Wide-field fundus image from infant ROP screening. Camera: Phoenix ICON (100° FOV)
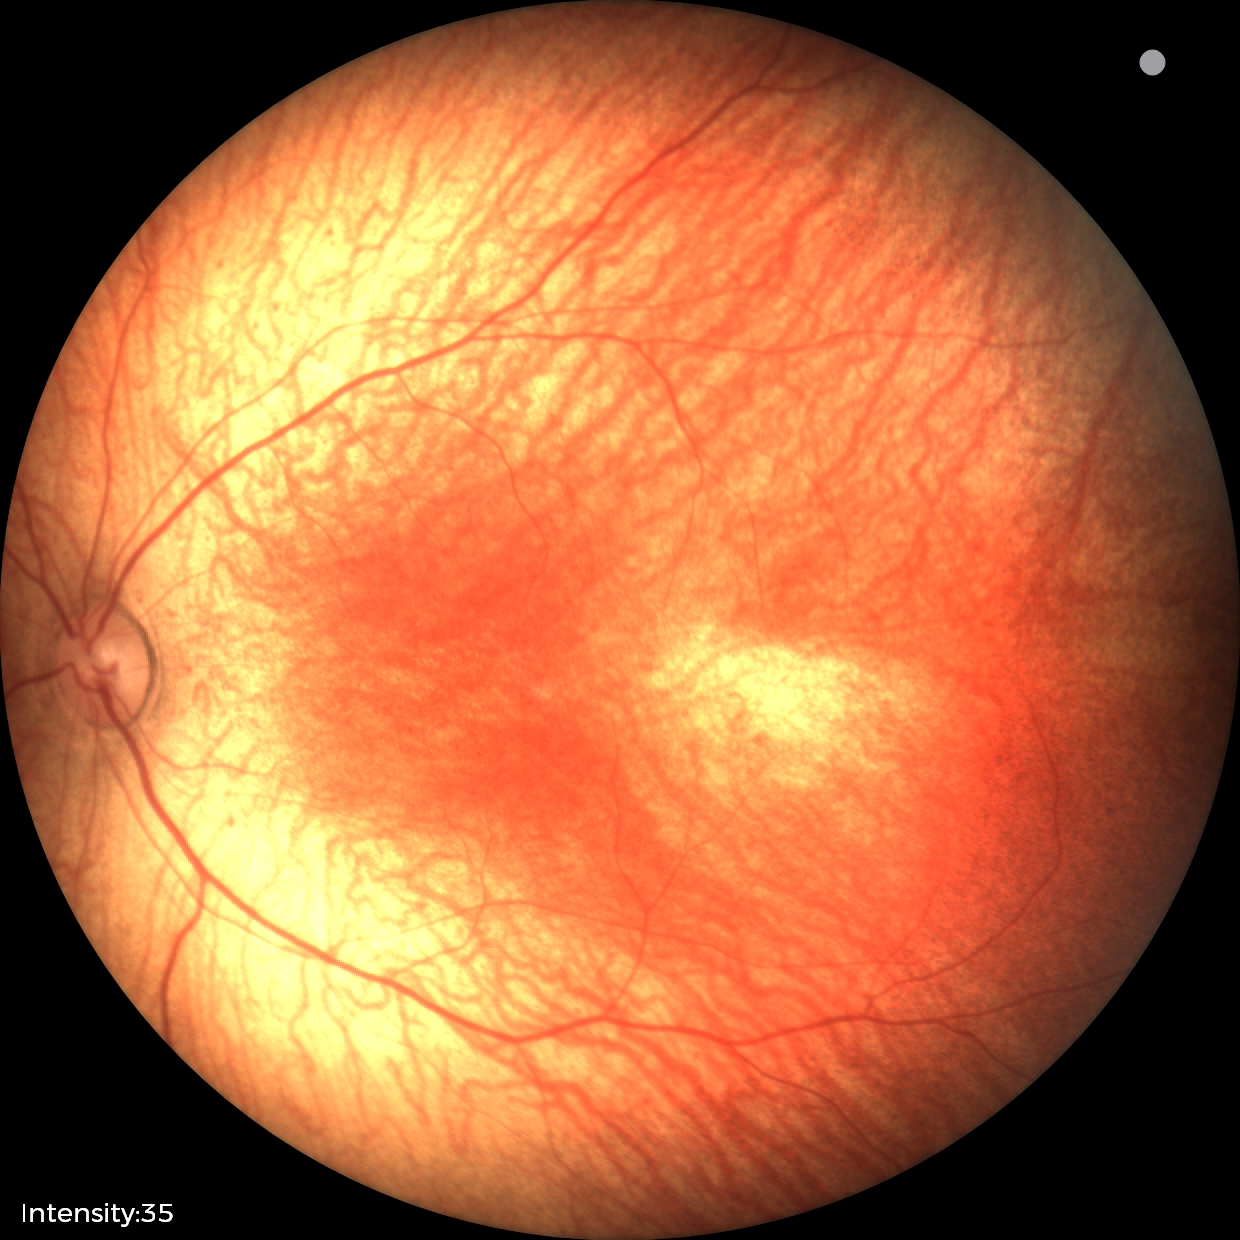
No retinal pathology identified on screening.